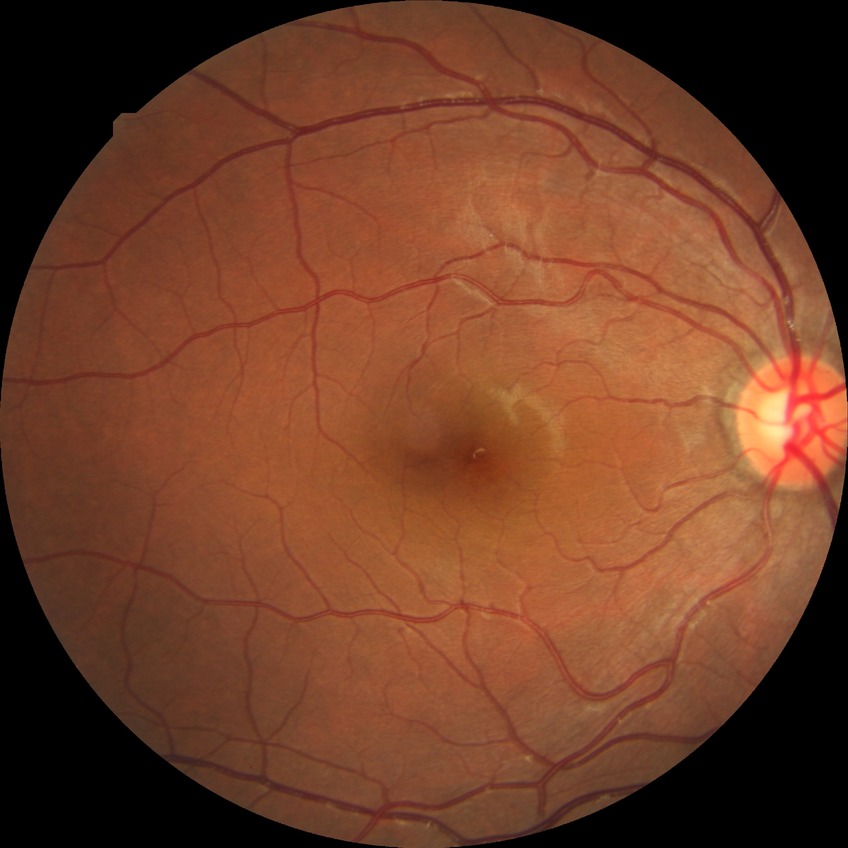
Diabetic retinopathy grade is no diabetic retinopathy.